Wide-field fundus image from infant ROP screening · 130° field of view (Clarity RetCam 3):
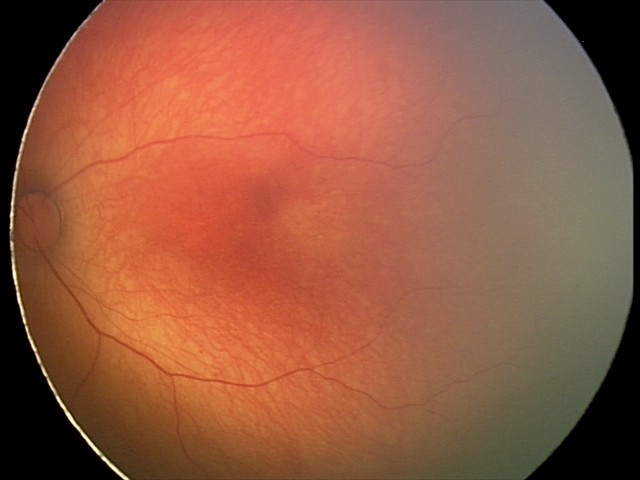
Examination with physiological retinal findings.